RetCam wide-field infant fundus image. Acquired on the Natus RetCam Envision:
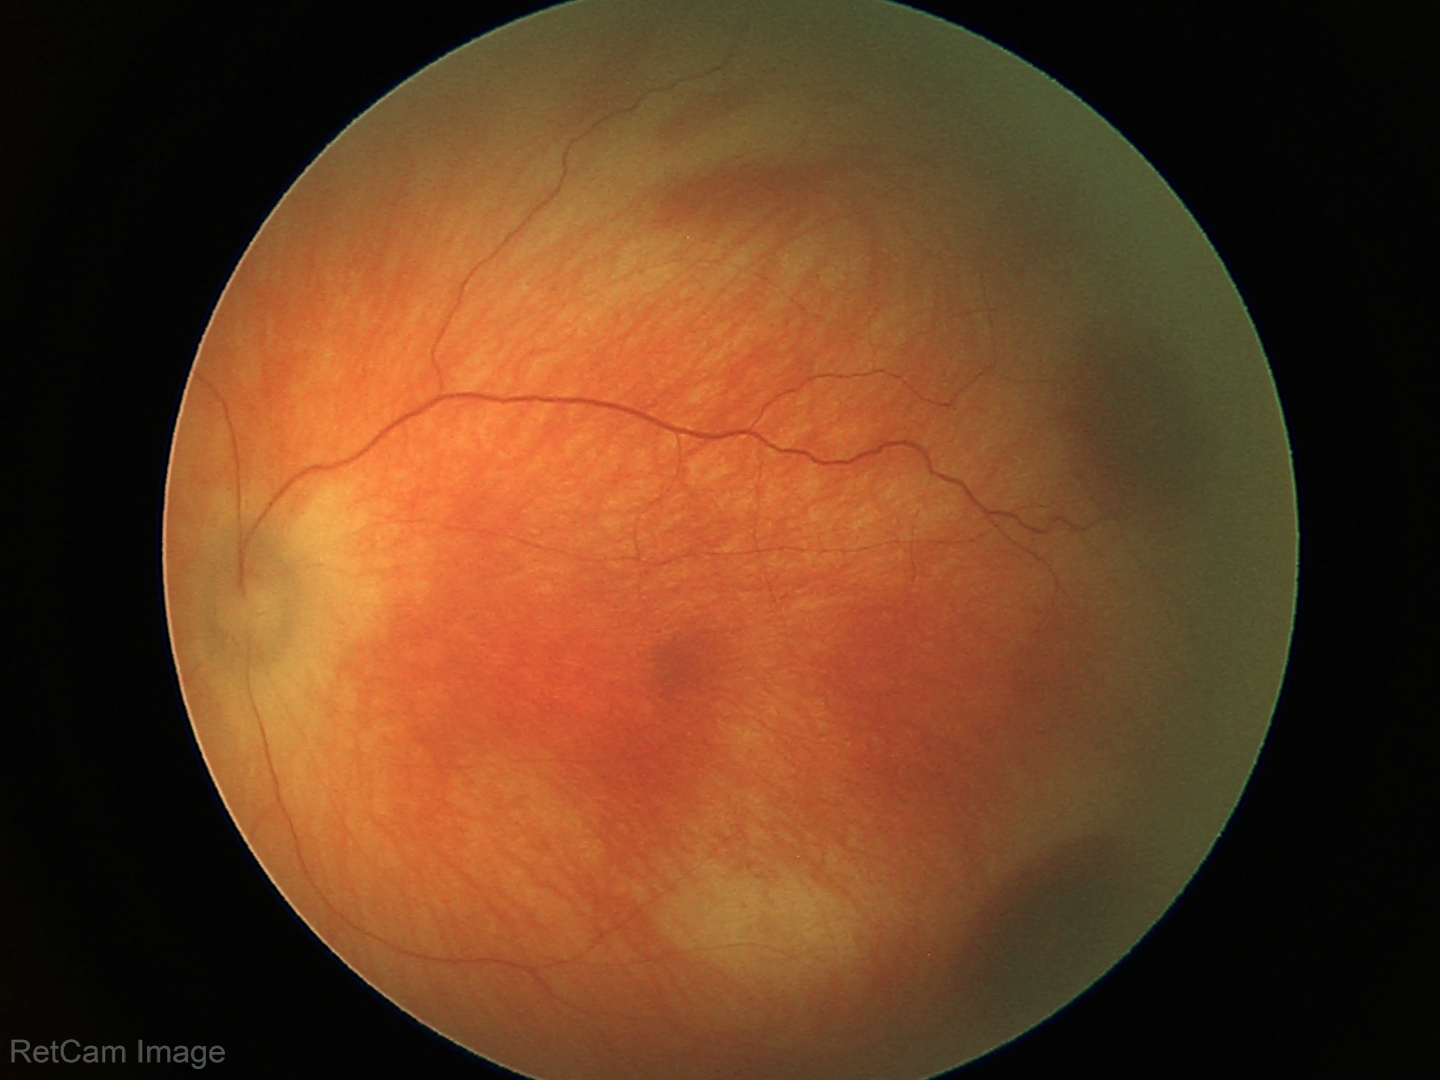
Impression = retinal hemorrhages.